130° field of view (Clarity RetCam 3). Wide-field fundus photograph of an infant: 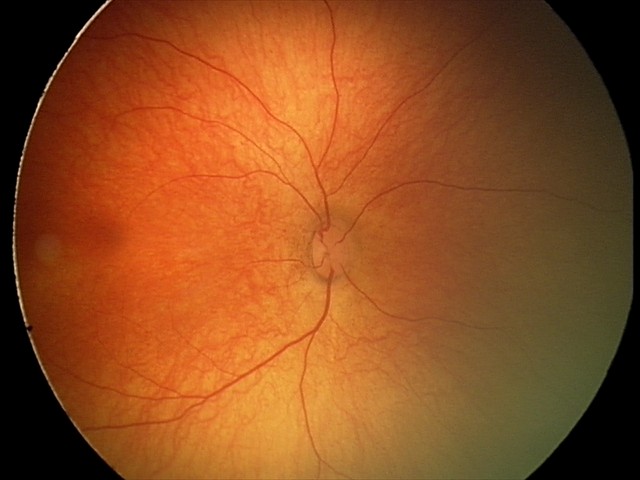 Examination with physiological retinal findings.